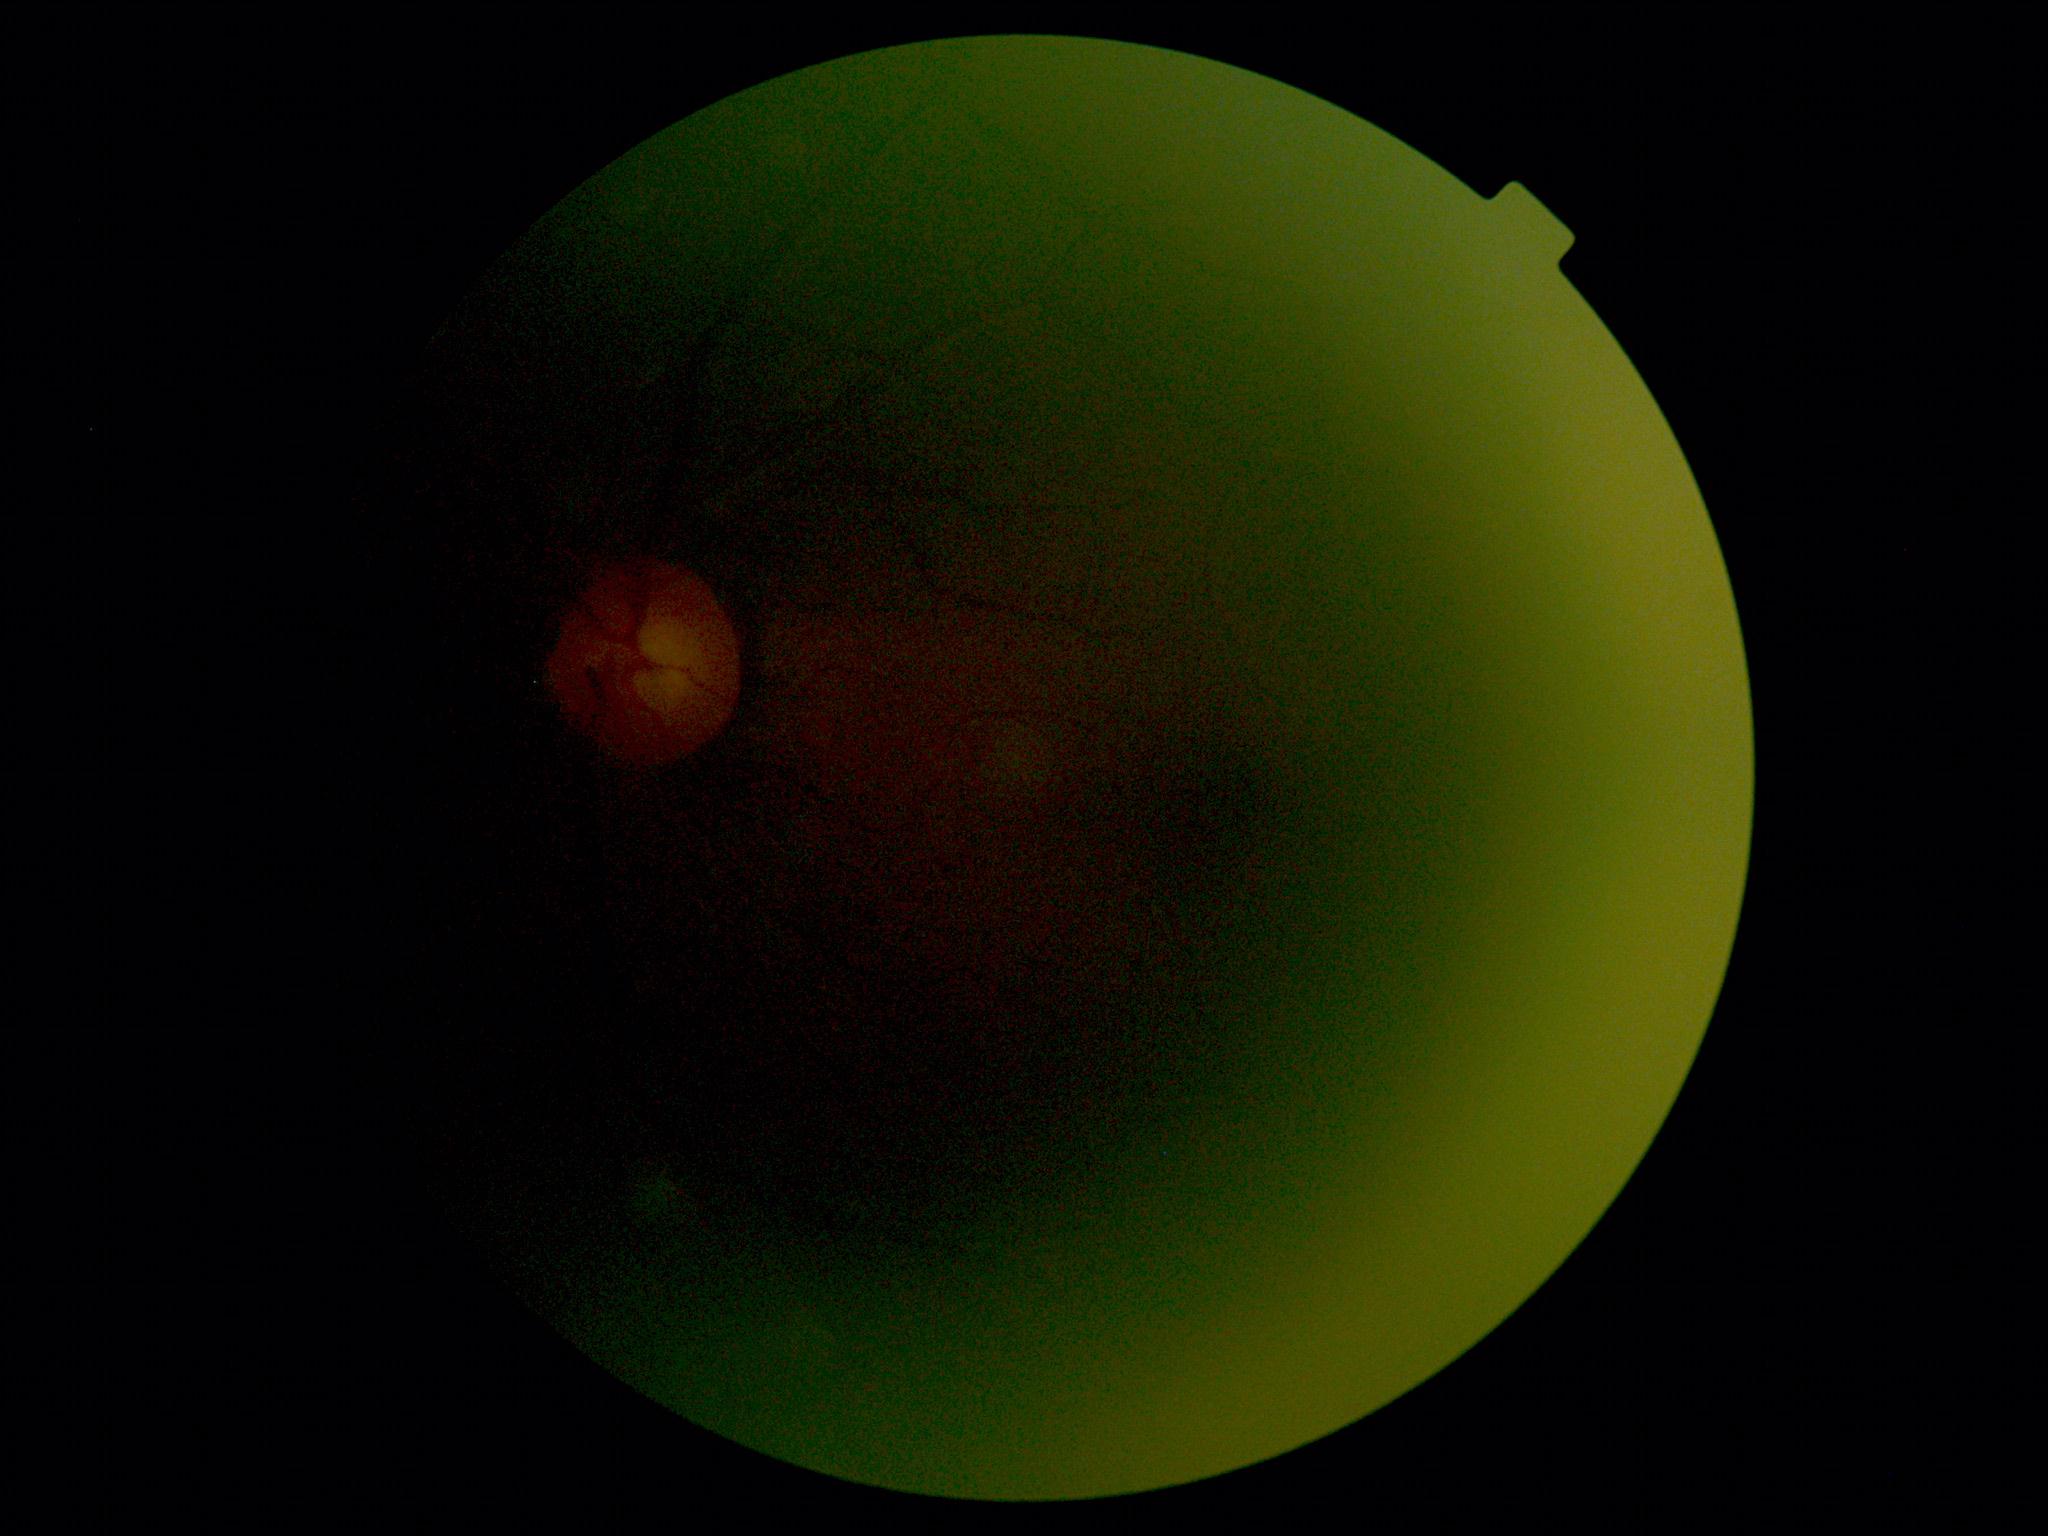
Annotations:
* DR severity — ungradable due to poor image quality